Nonmydriatic, image size 848x848, FOV: 45 degrees: 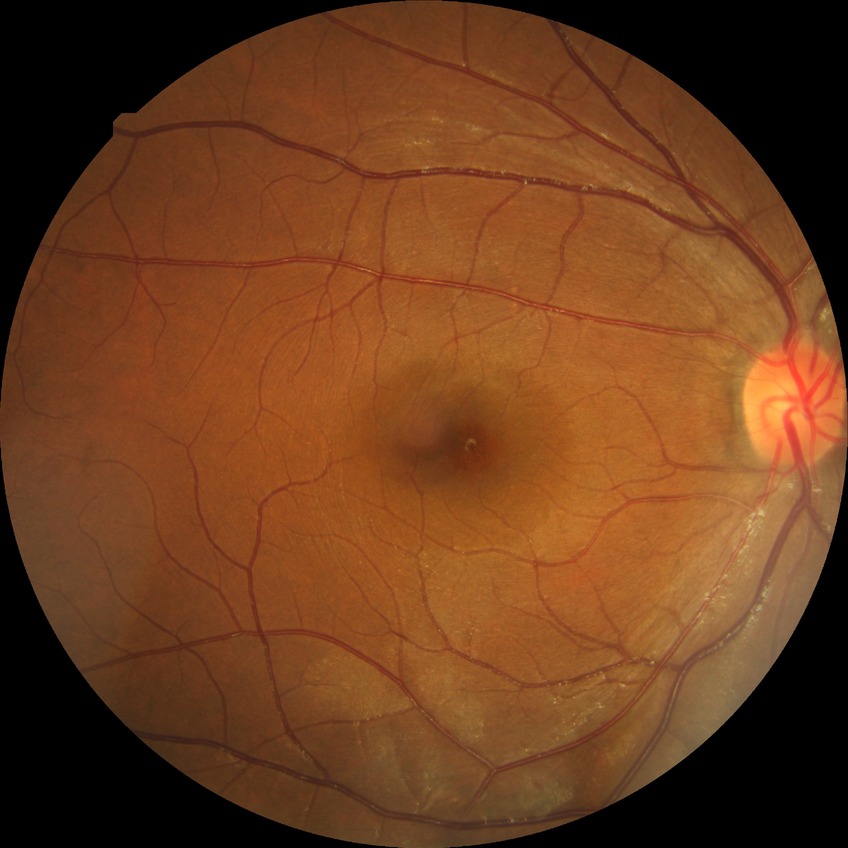
Diabetic retinopathy (DR): no diabetic retinopathy (NDR).